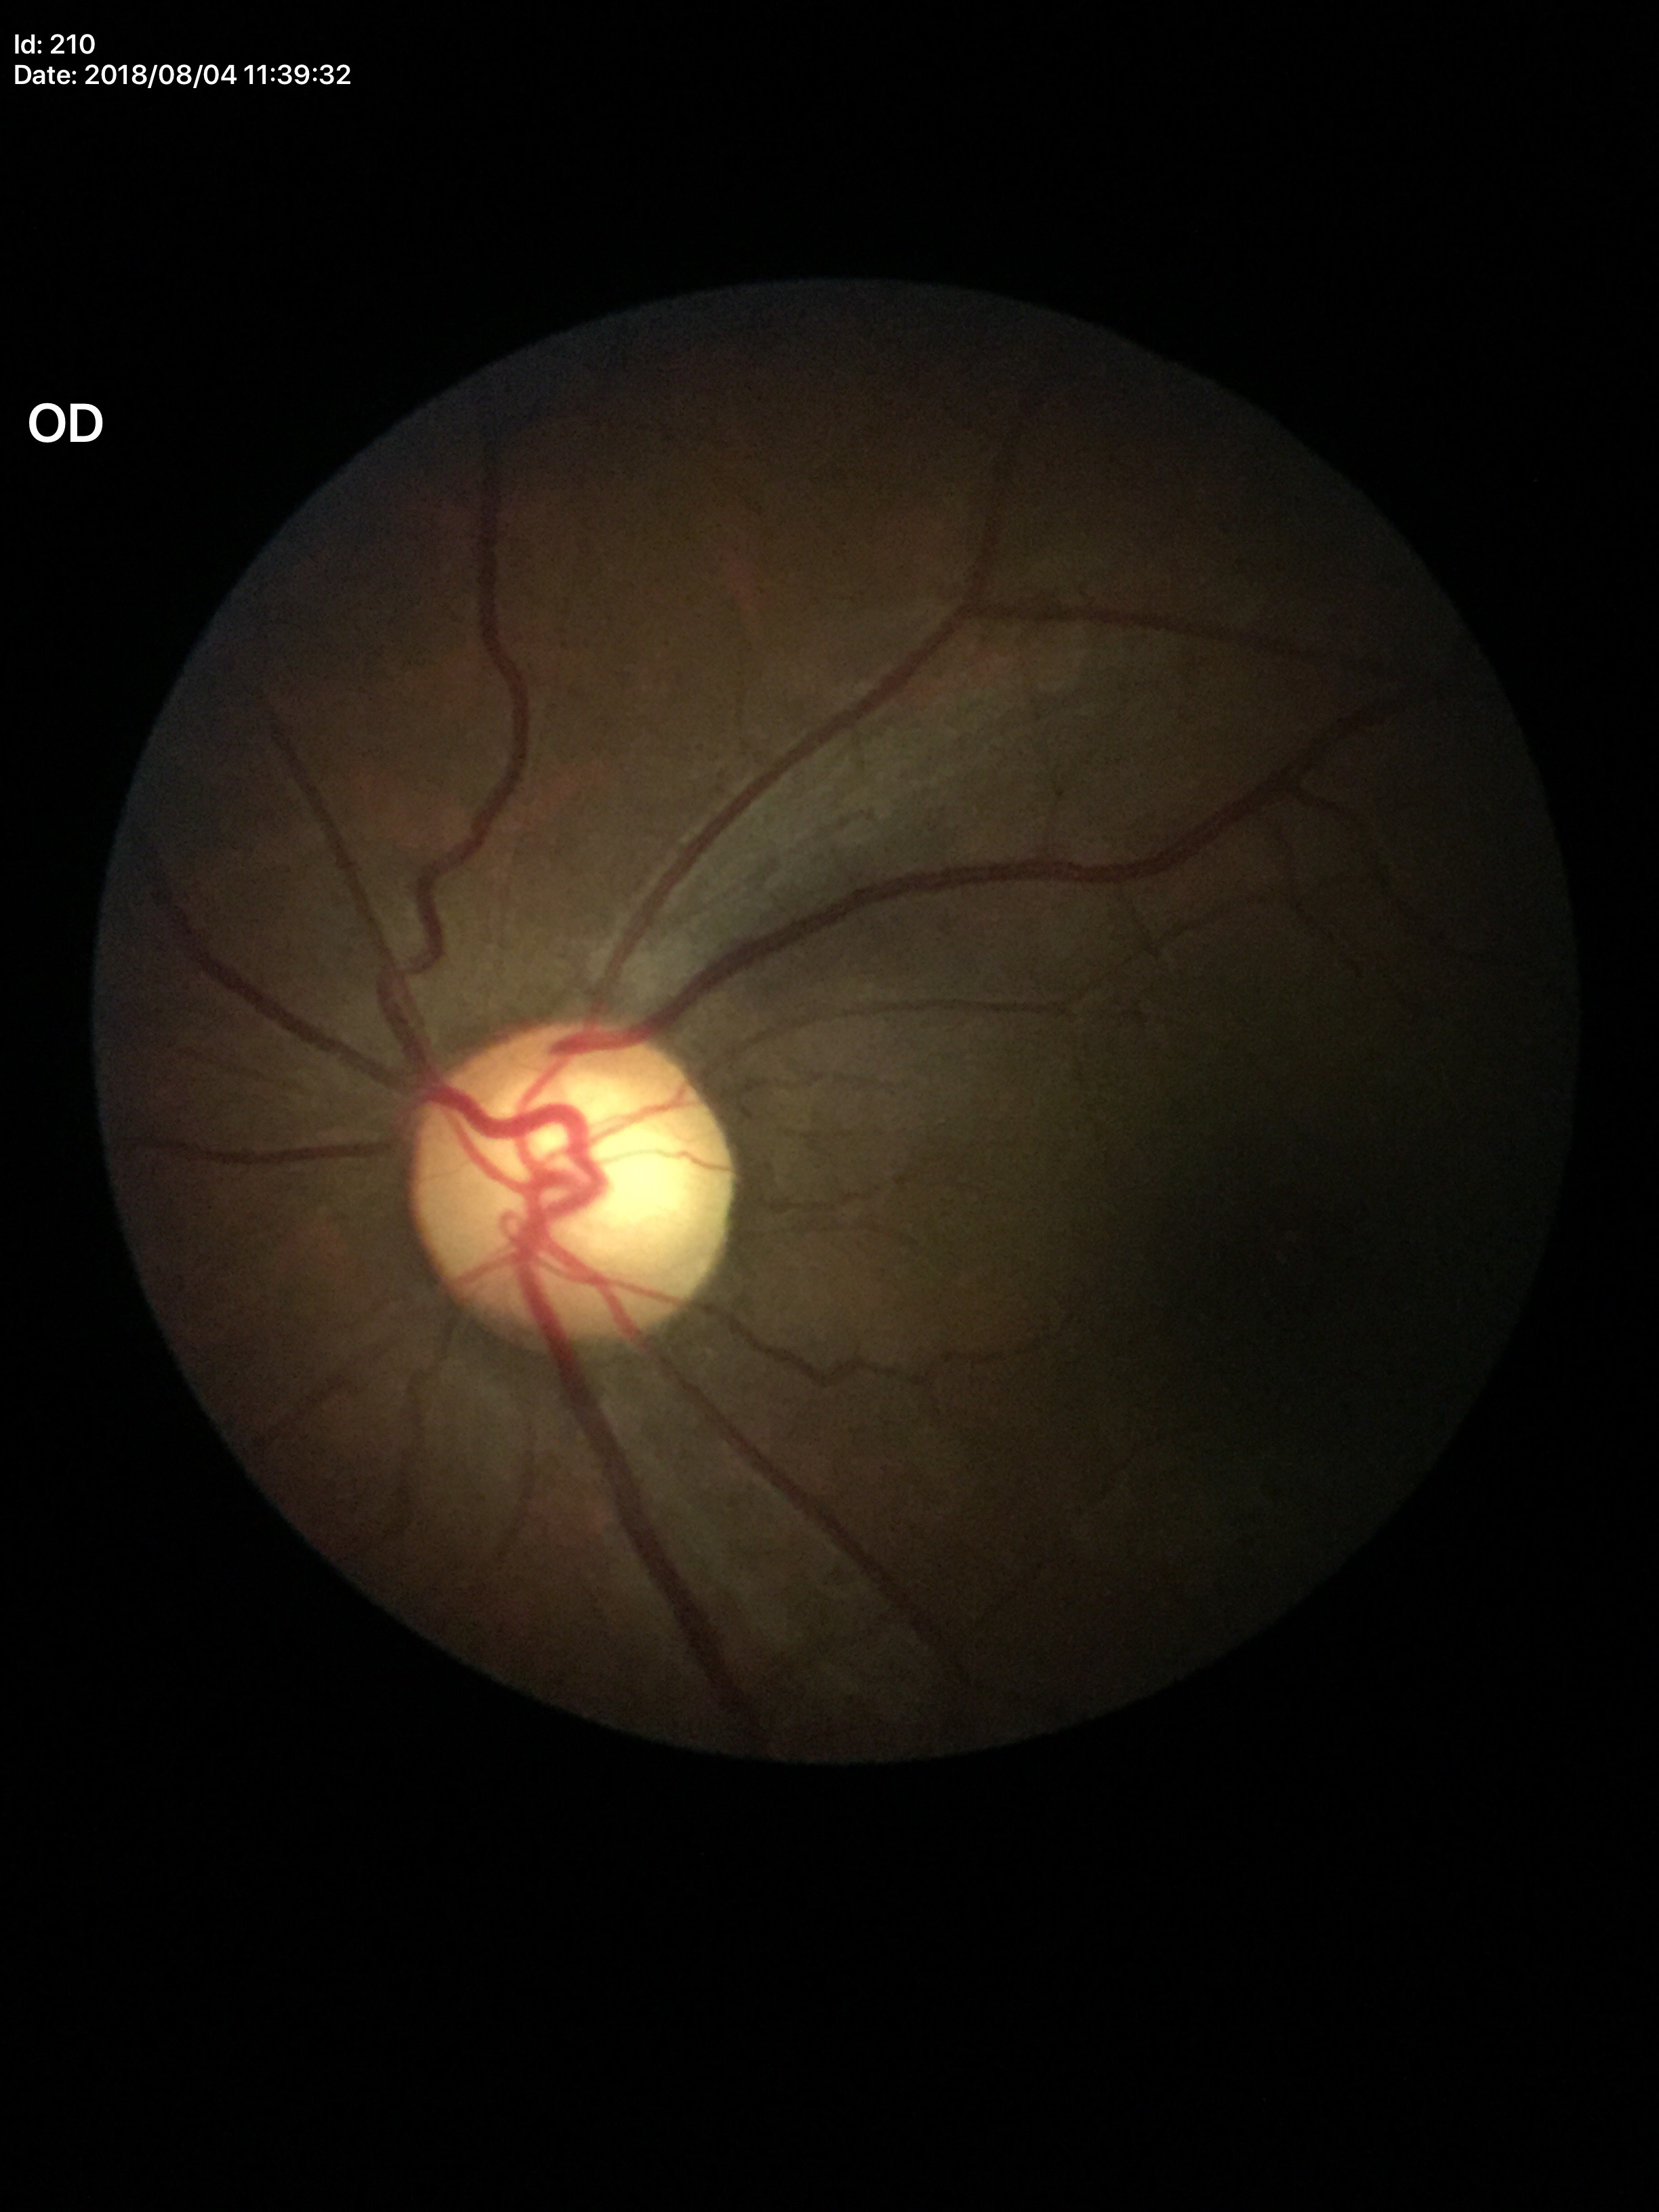 ACDR: 0.48. Suspect for glaucomatous optic neuropathy. VCDR is 0.69.